Fundus photo:
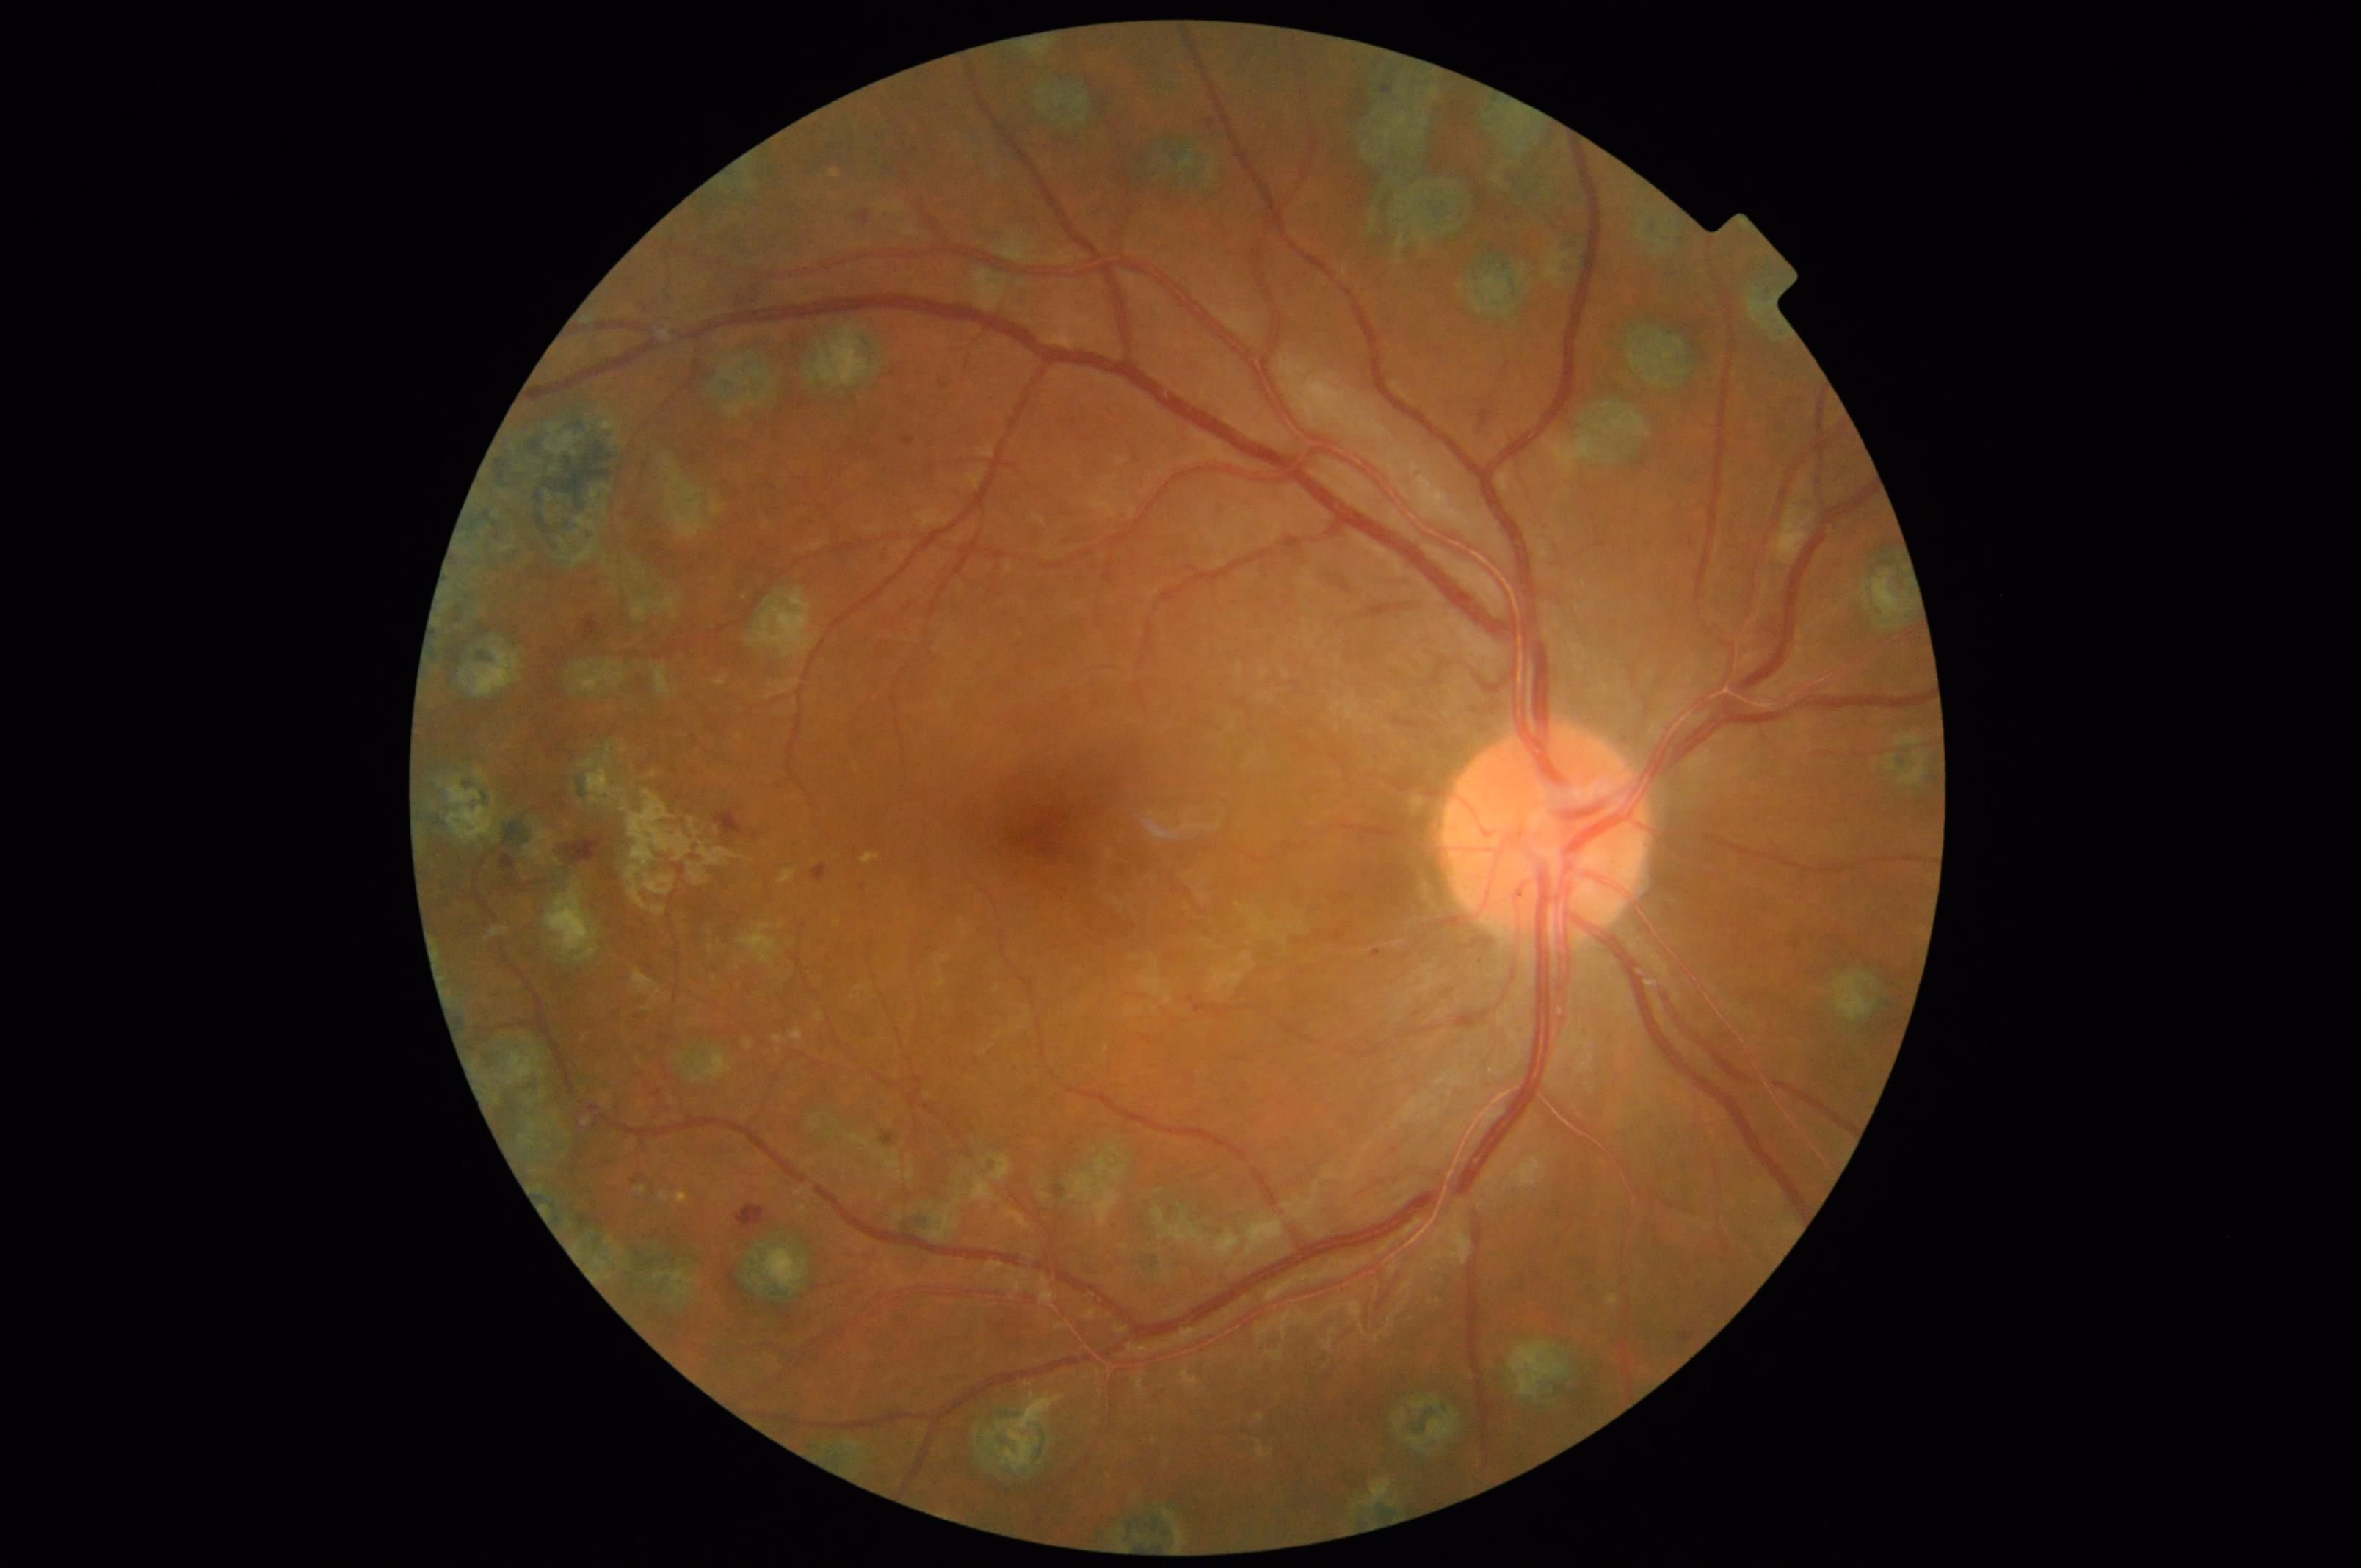 Image quality assessment: clarity: in focus | contrast: good | overall: acceptable | illumination: good.